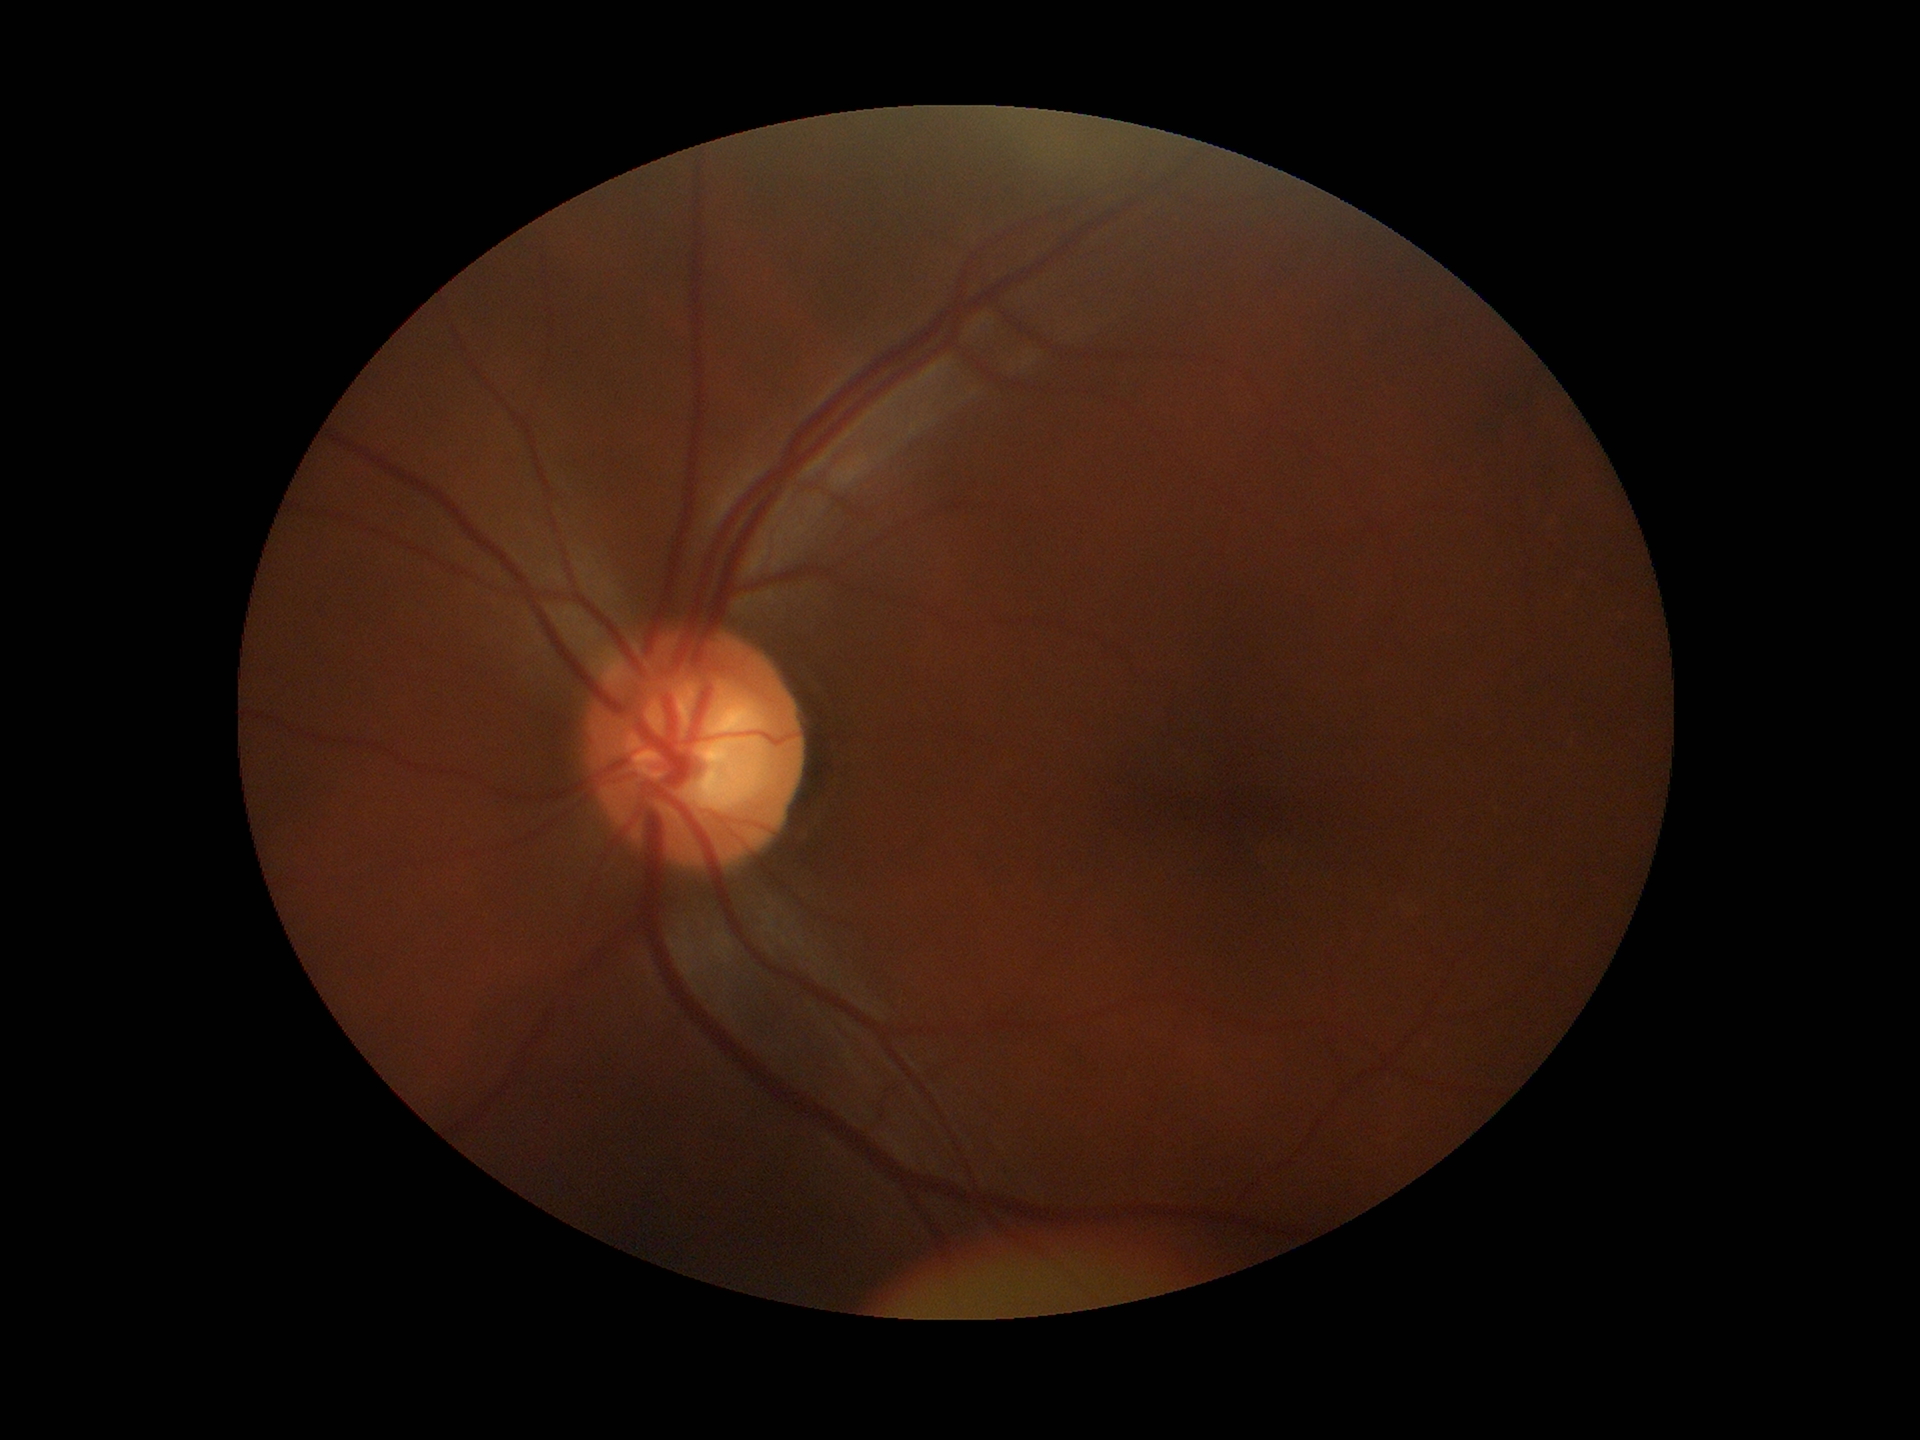 {"glaucoma_decision": "suspect", "vcdr": "0.62", "hcdr": "0.66"}